Captured without pupil dilation, color fundus image, optic disc region crop
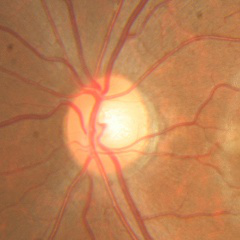 Glaucoma stage = no glaucomatous changes.